Modified Davis grading: 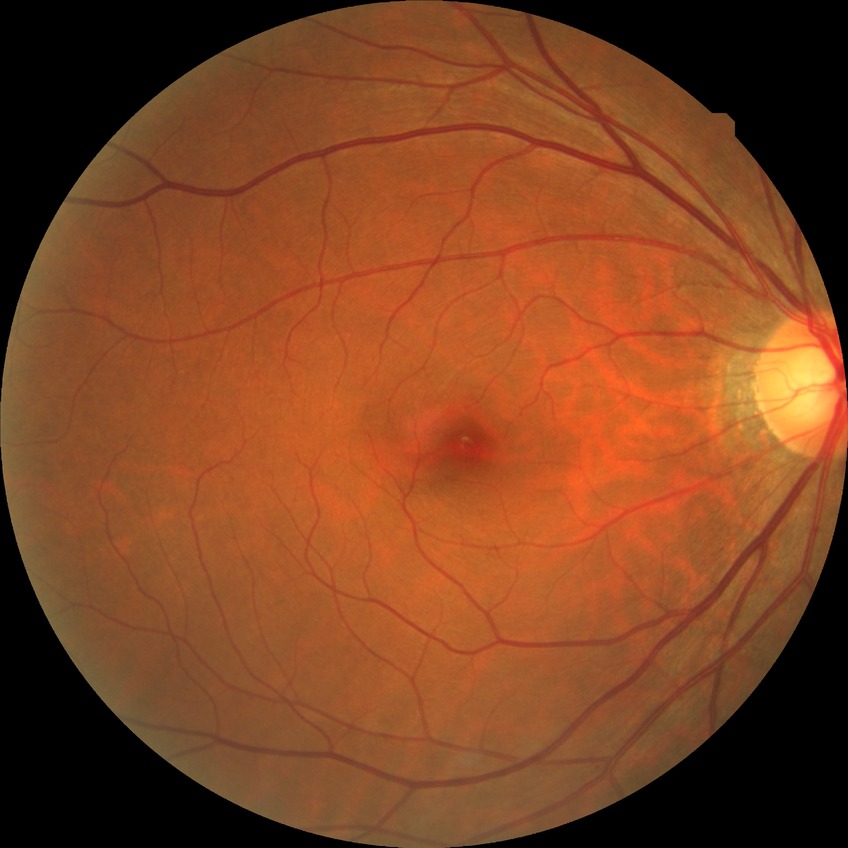
Diabetic retinopathy severity: no diabetic retinopathy.